FOV: 45 degrees:
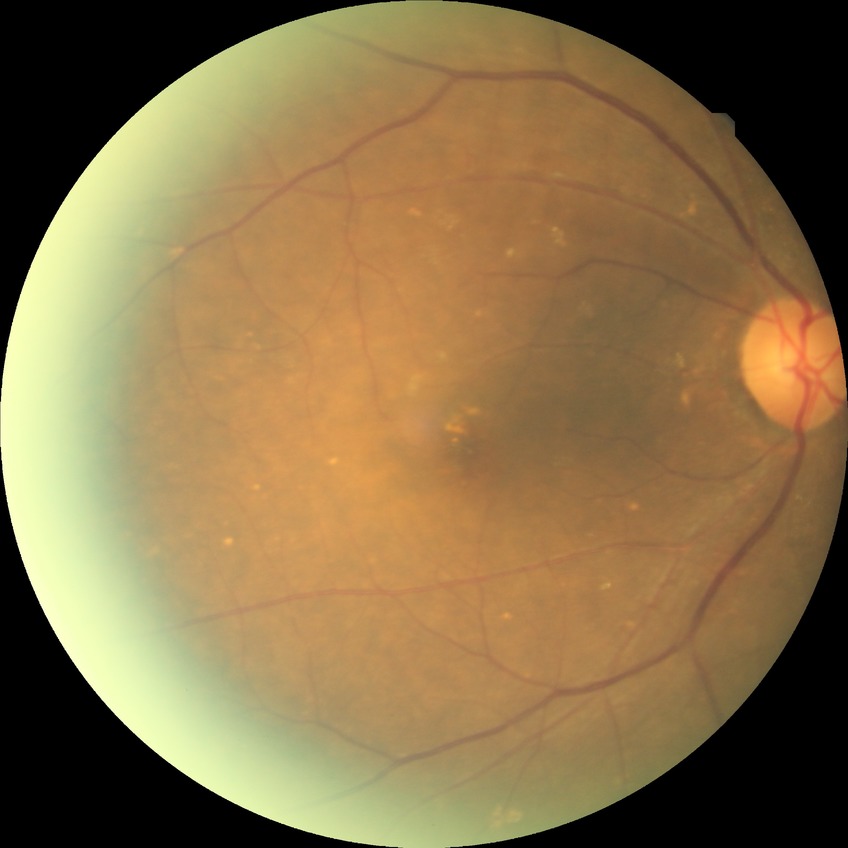

retinopathy stage = no diabetic retinopathy.